2352x1568px, color fundus image: 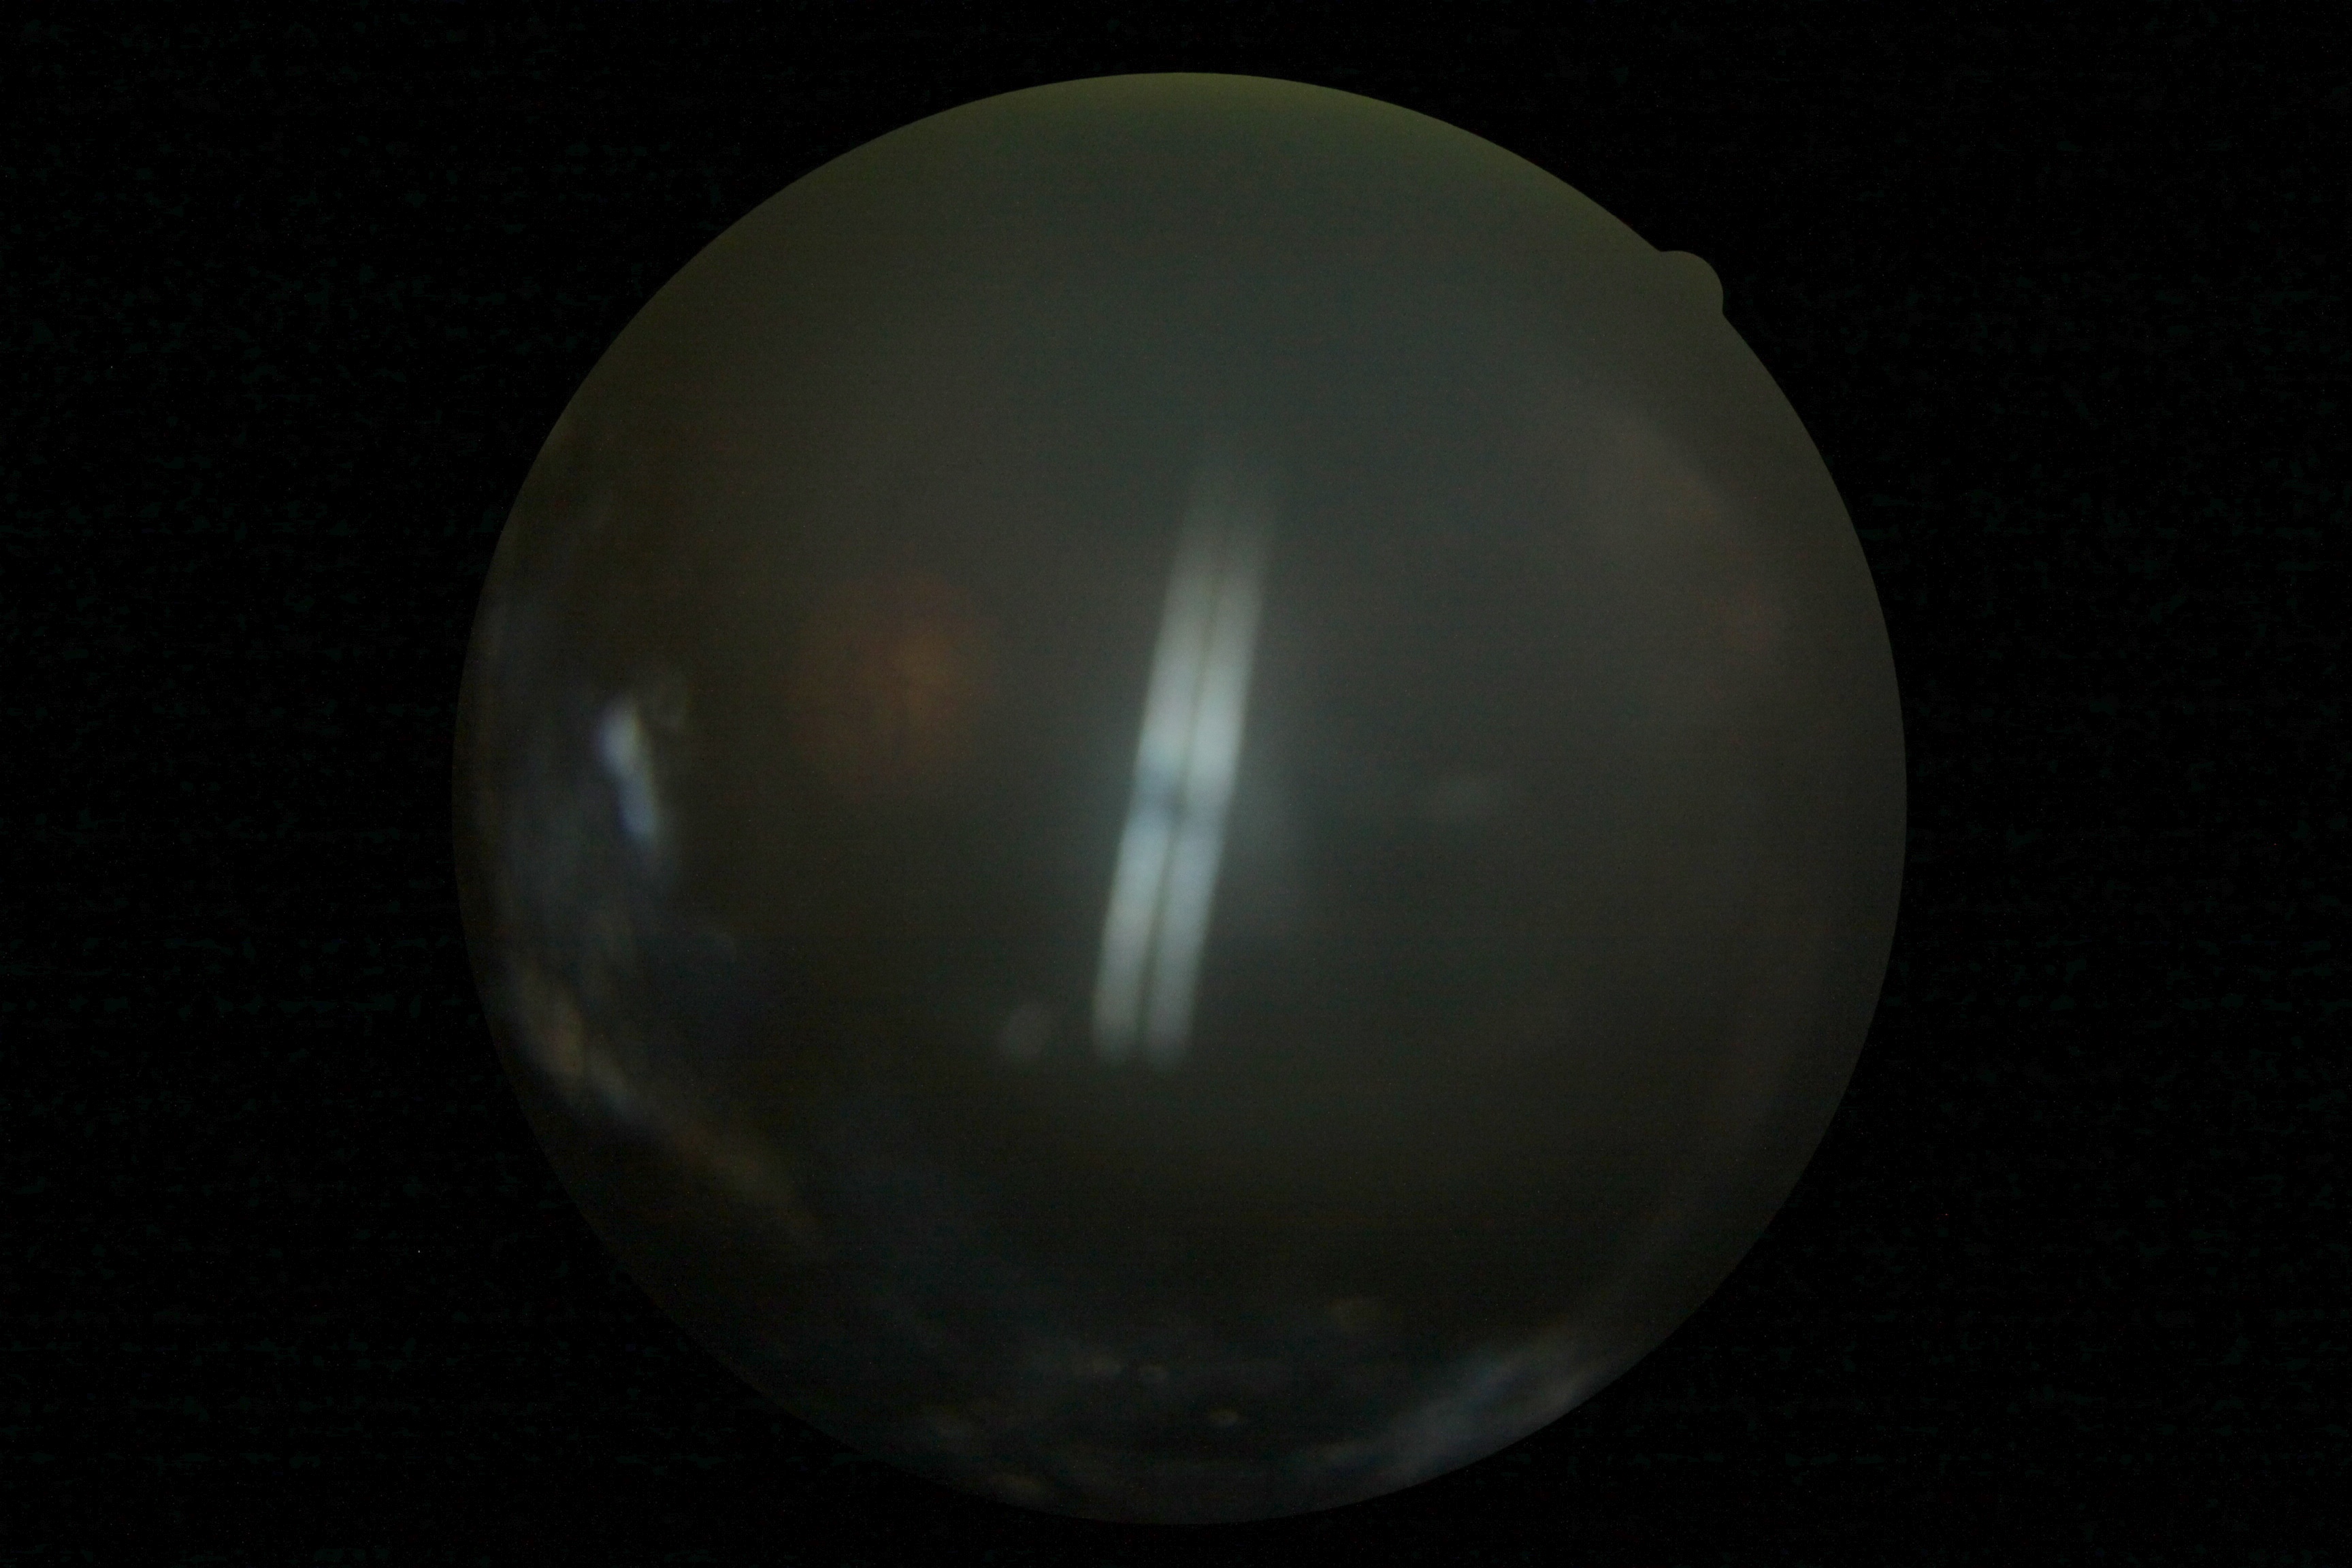
image quality: insufficient, DR grade: ungradable.